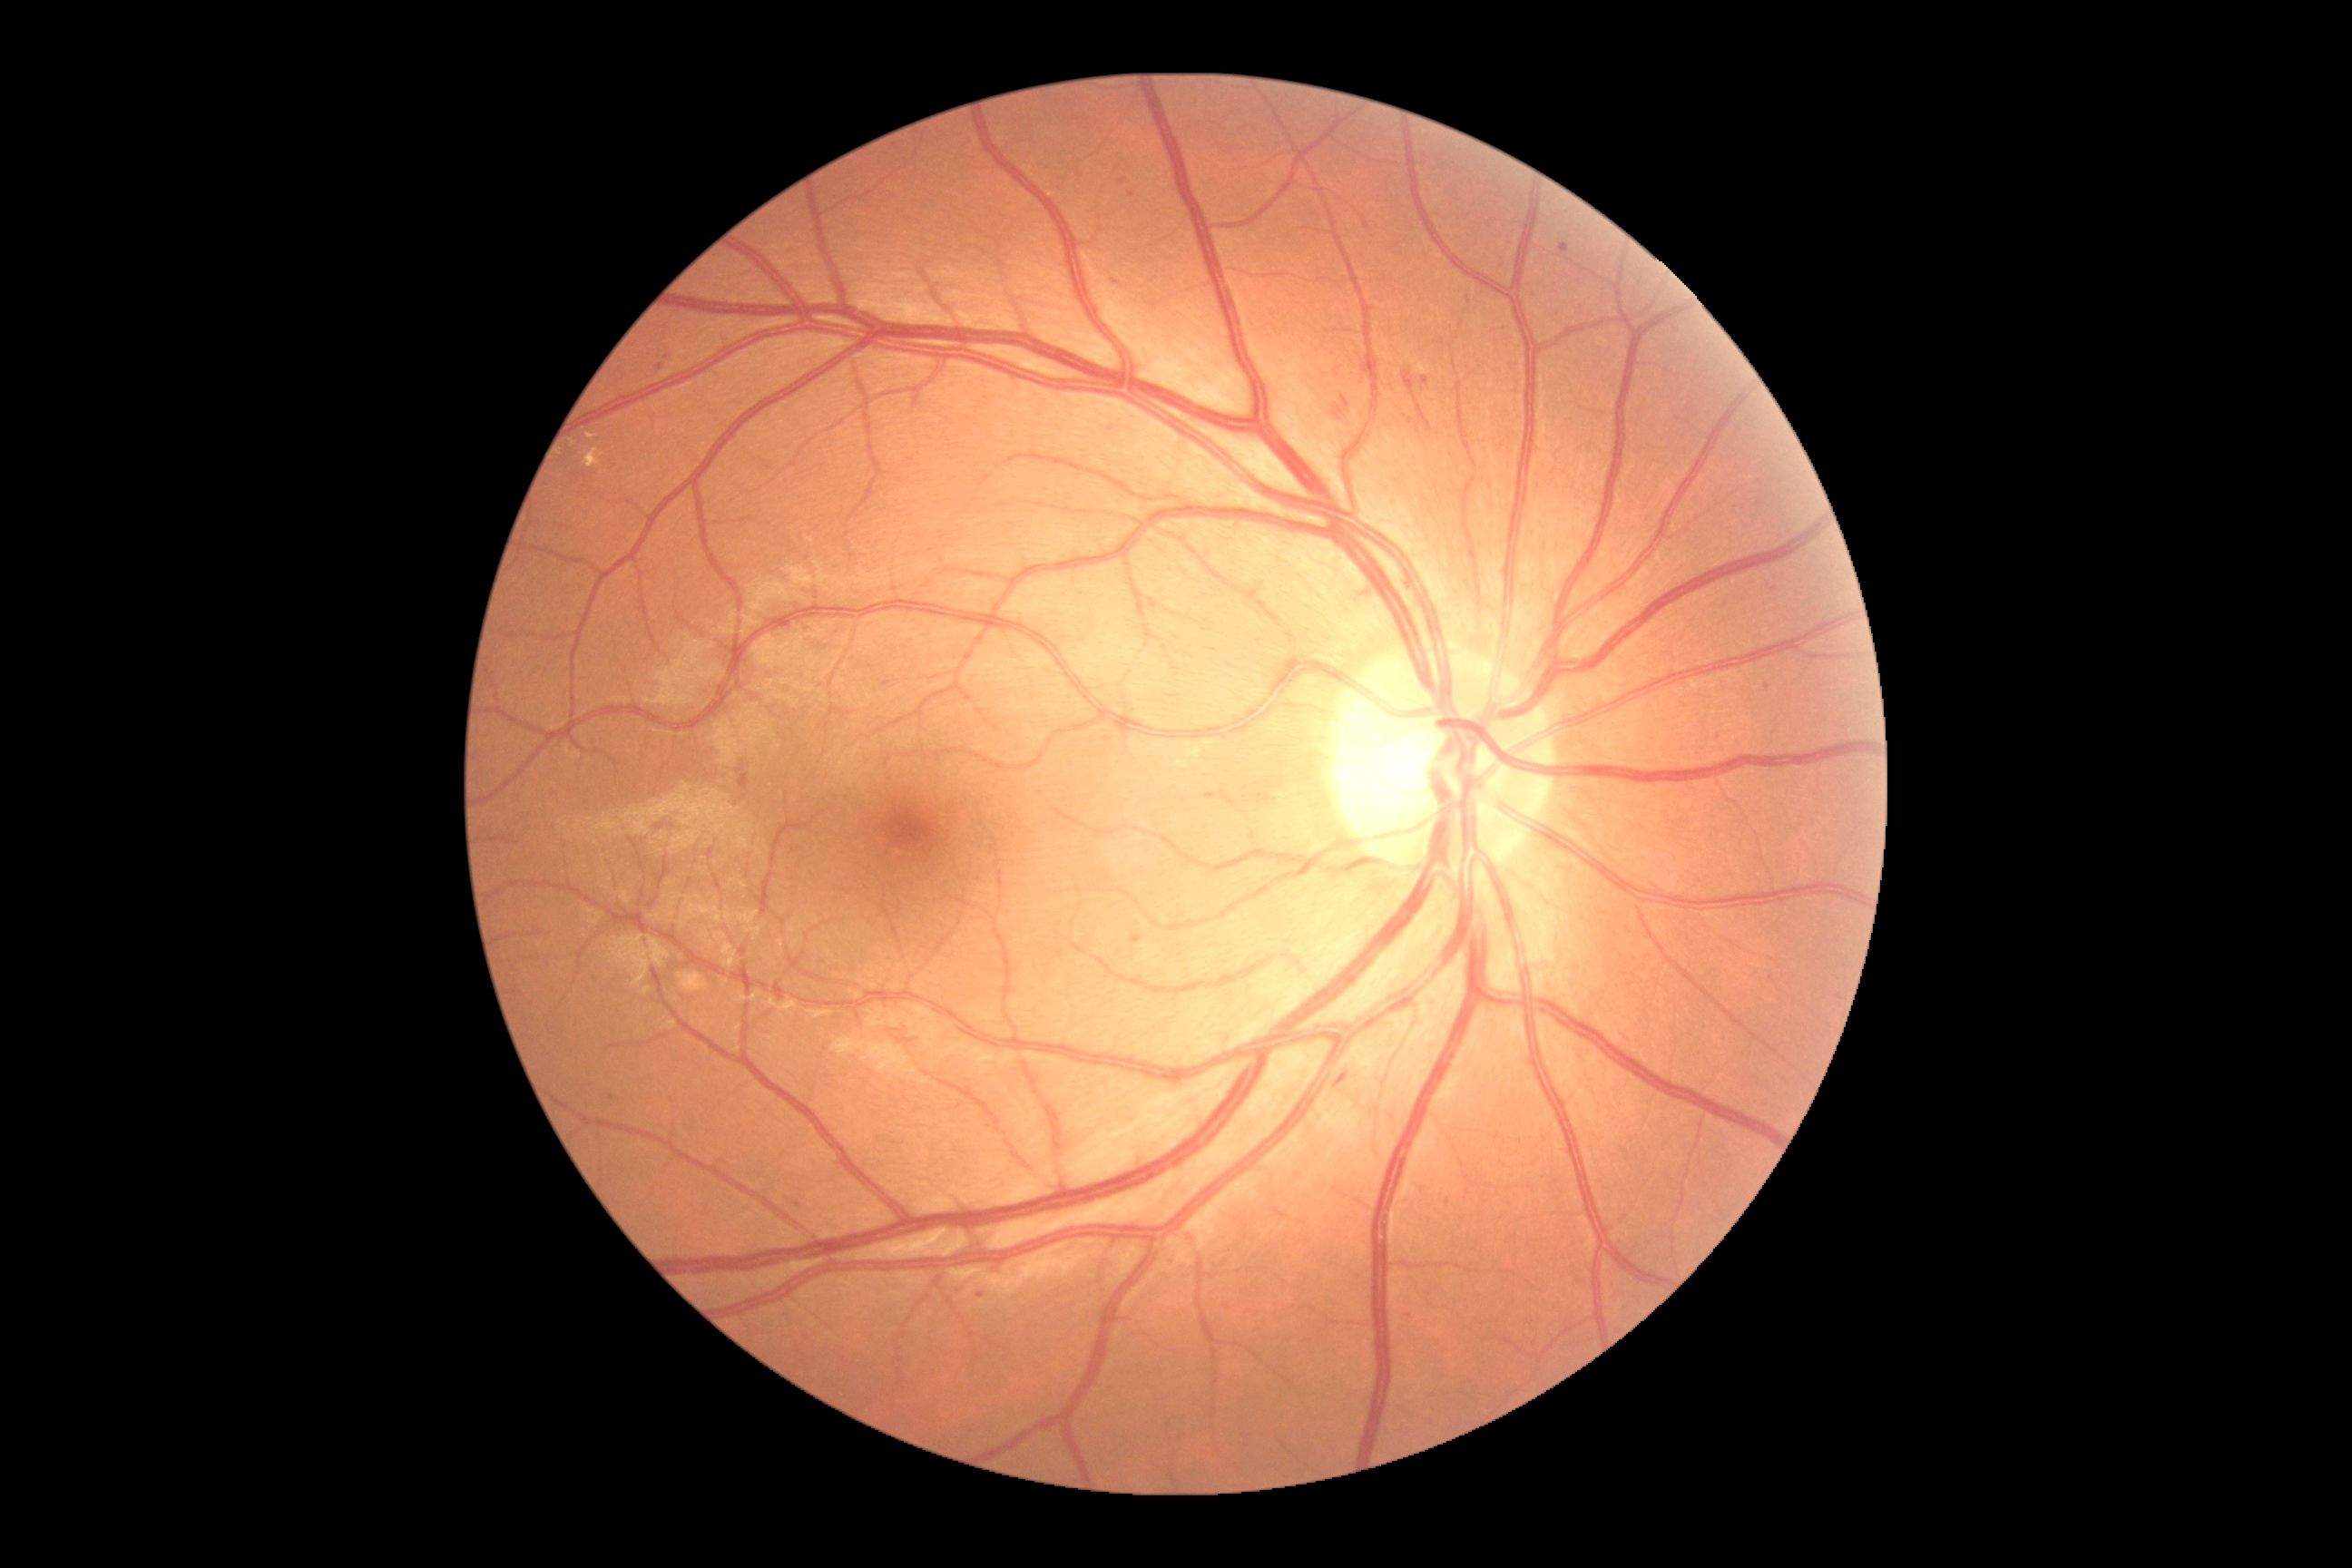

Diabetic retinopathy (DR) is grade 2 (moderate NPDR)
Lesions identified (partial list):
* hard exudates (EXs): {"left": 1202, "top": 741, "right": 1215, "bottom": 749}; {"left": 1177, "top": 761, "right": 1190, "bottom": 769}; {"left": 583, "top": 449, "right": 605, "bottom": 469}; {"left": 587, "top": 435, "right": 598, "bottom": 440}; {"left": 1186, "top": 745, "right": 1202, "bottom": 765}
* Small EXs near <pt>573,443</pt>
* soft exudates (SEs): none
* hemorrhages (HEs): {"left": 1404, "top": 371, "right": 1433, "bottom": 433}; {"left": 1342, "top": 397, "right": 1351, "bottom": 409}; {"left": 1335, "top": 1073, "right": 1349, "bottom": 1088}; {"left": 1333, "top": 406, "right": 1346, "bottom": 422}
* microaneurysms (MAs) (subset): {"left": 1712, "top": 729, "right": 1720, "bottom": 740}; {"left": 785, "top": 250, "right": 794, "bottom": 255}; {"left": 1128, "top": 191, "right": 1135, "bottom": 199}; {"left": 1560, "top": 244, "right": 1571, "bottom": 253}; {"left": 1769, "top": 975, "right": 1774, "bottom": 983}; {"left": 738, "top": 774, "right": 749, "bottom": 789}; {"left": 1119, "top": 179, "right": 1128, "bottom": 186}
* Small MAs near <pt>1425,157</pt>; <pt>661,368</pt>; <pt>1412,421</pt>; <pt>982,1295</pt>